Non-mydriatic fundus camera.
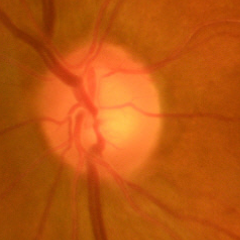

Findings consistent with no glaucomatous changes.